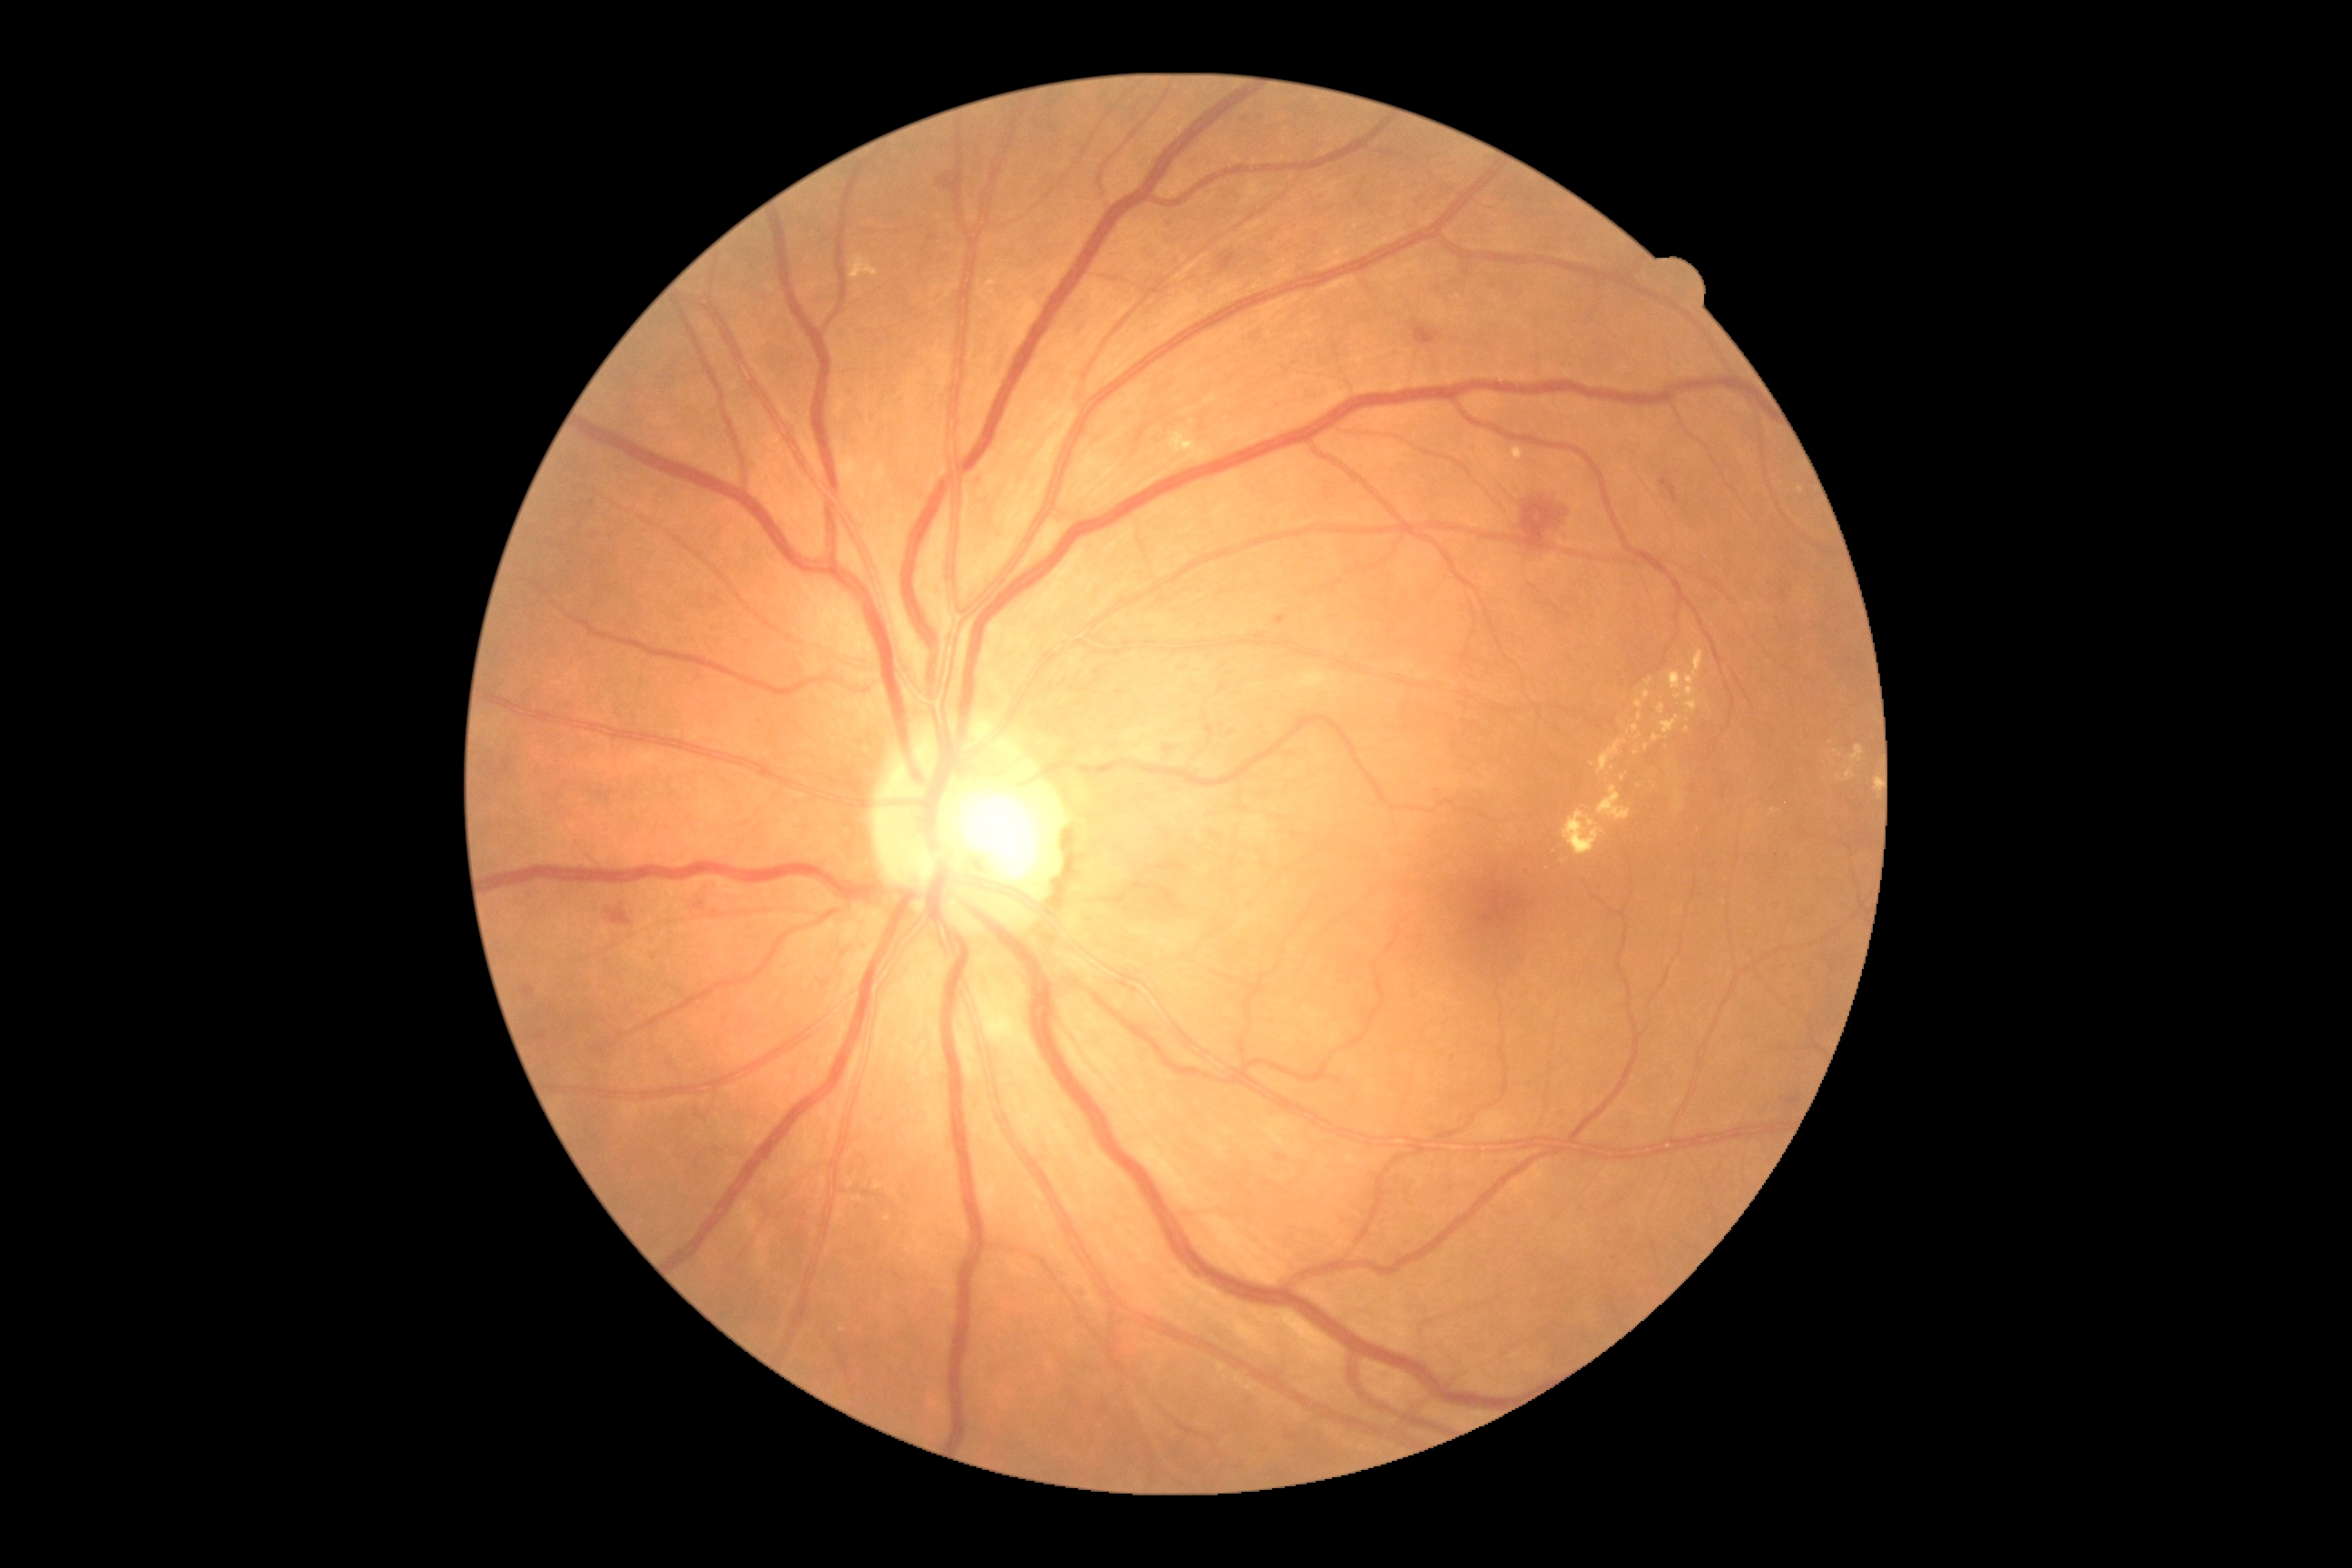

Diabetic retinopathy grade: moderate NPDR (2).